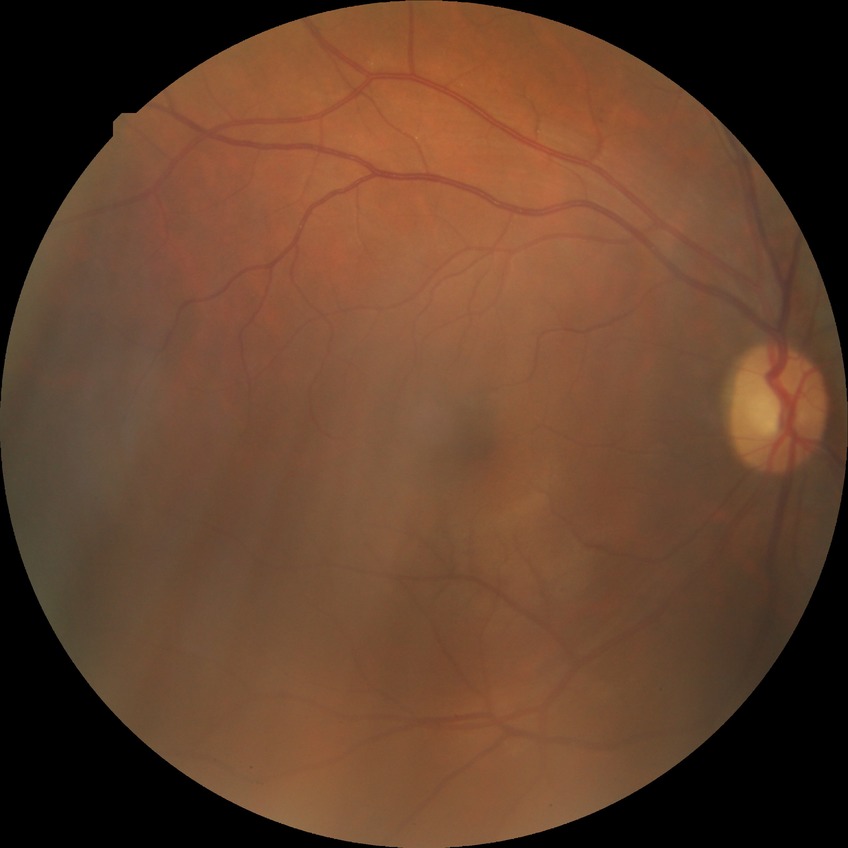
Diabetic retinopathy (DR) is no diabetic retinopathy (NDR).